640x480. Camera: Clarity RetCam 3 (130° FOV). Pediatric retinal photograph (wide-field)
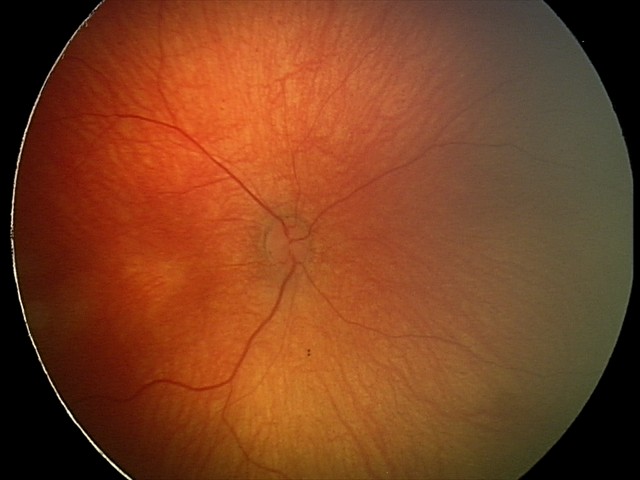

Finding = normal retinal appearance